Nonmydriatic fundus photograph, FOV: 45 degrees, 848 by 848 pixels, color fundus photograph, modified Davis grading: 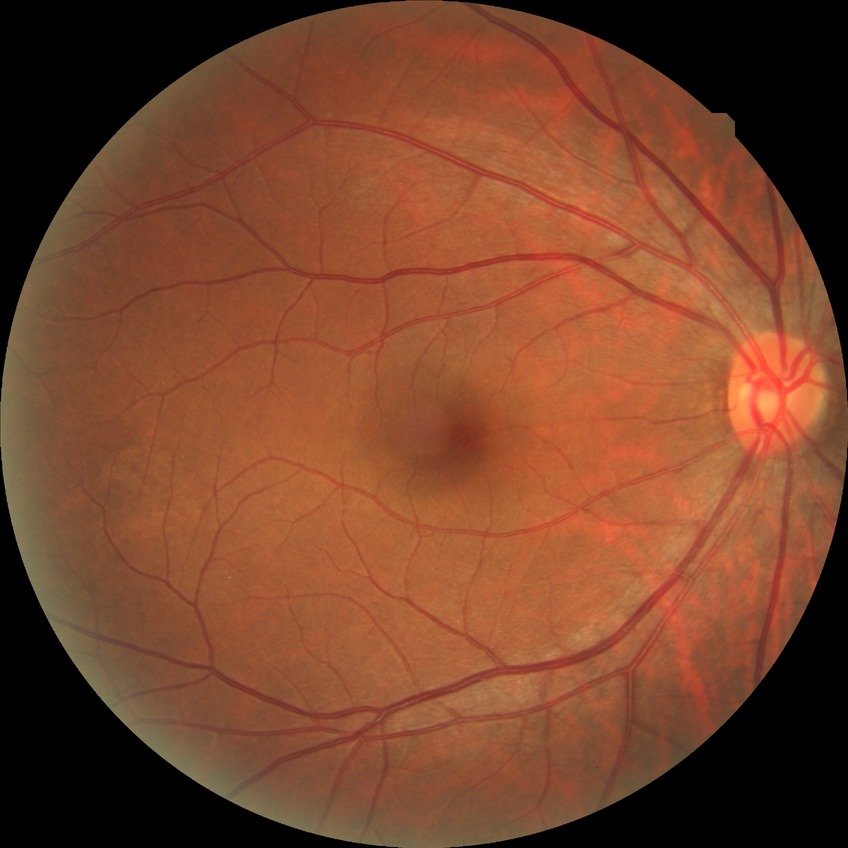 Annotations:
* modified Davis grading — no diabetic retinopathy